Retinal fundus photograph, 848x848px, graded on the modified Davis scale
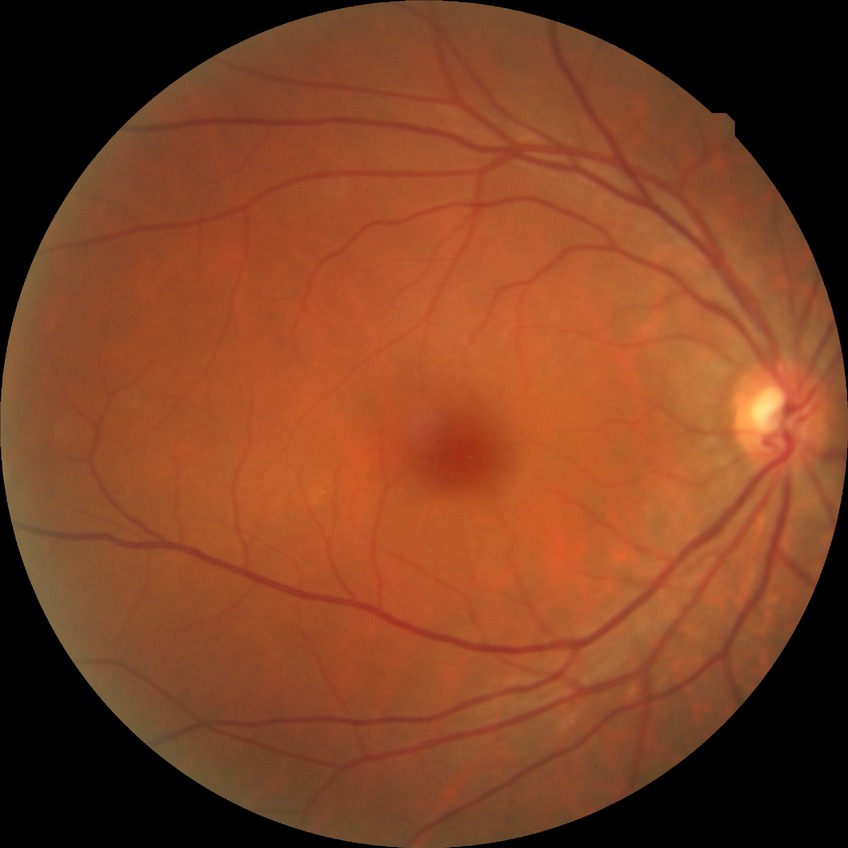
Diabetic retinopathy (DR) is NDR (no diabetic retinopathy).